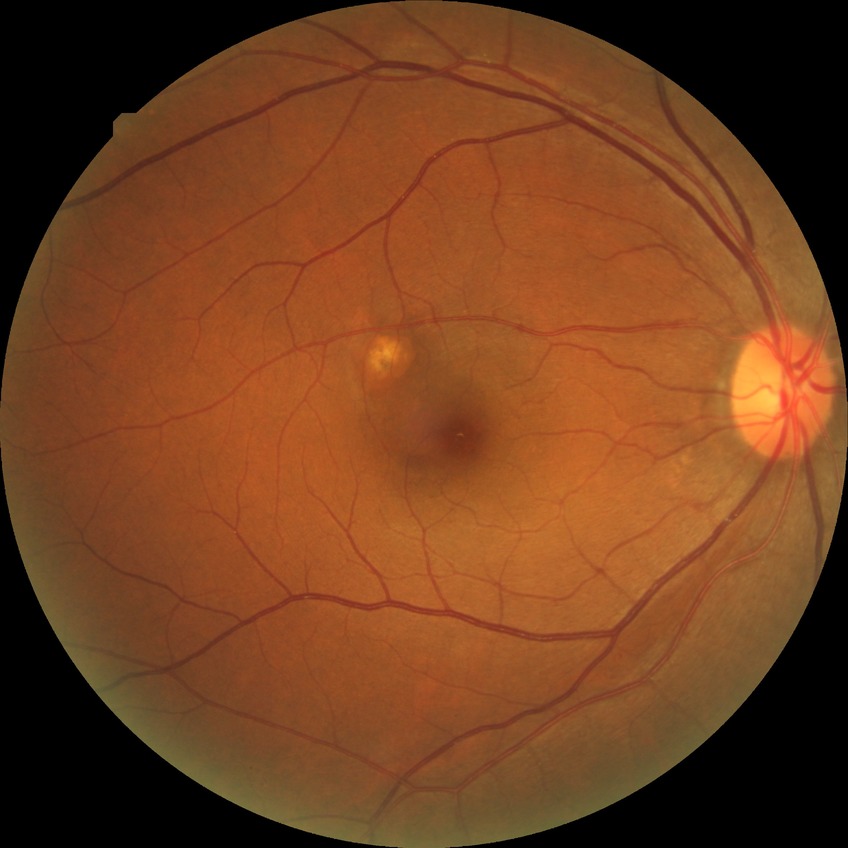

Retinopathy grade: no diabetic retinopathy.